Wide-field retinal mosaic image. 200-degree field of view. 1924 by 1556 pixels:
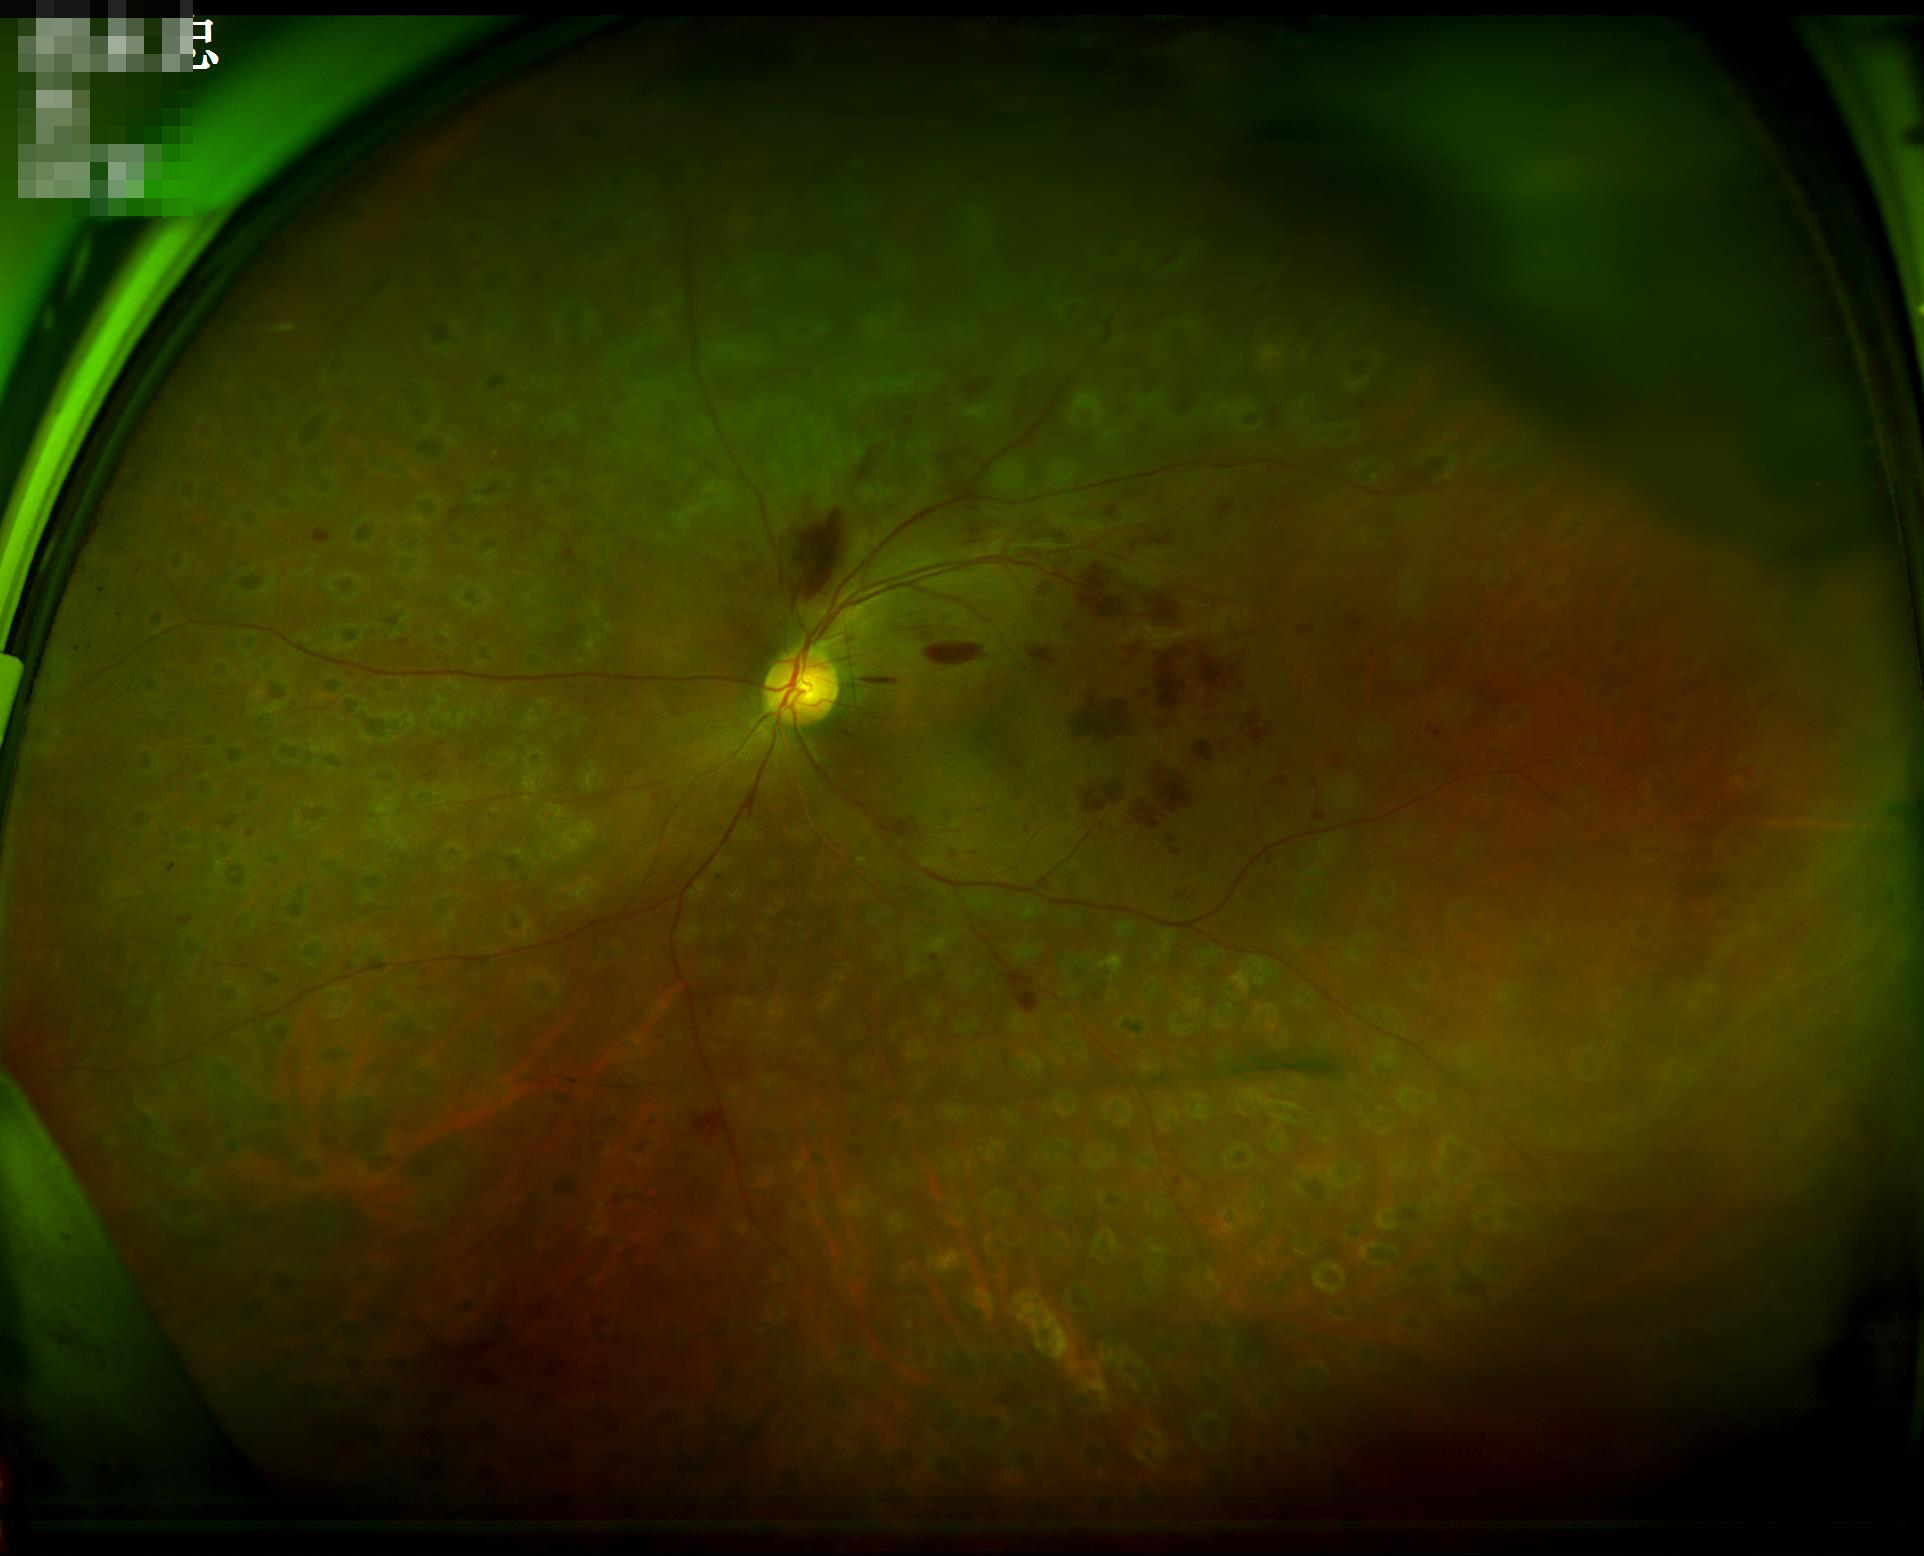

Quality assessment: overall: satisfactory; focus: sharp.